Infant wide-field retinal image
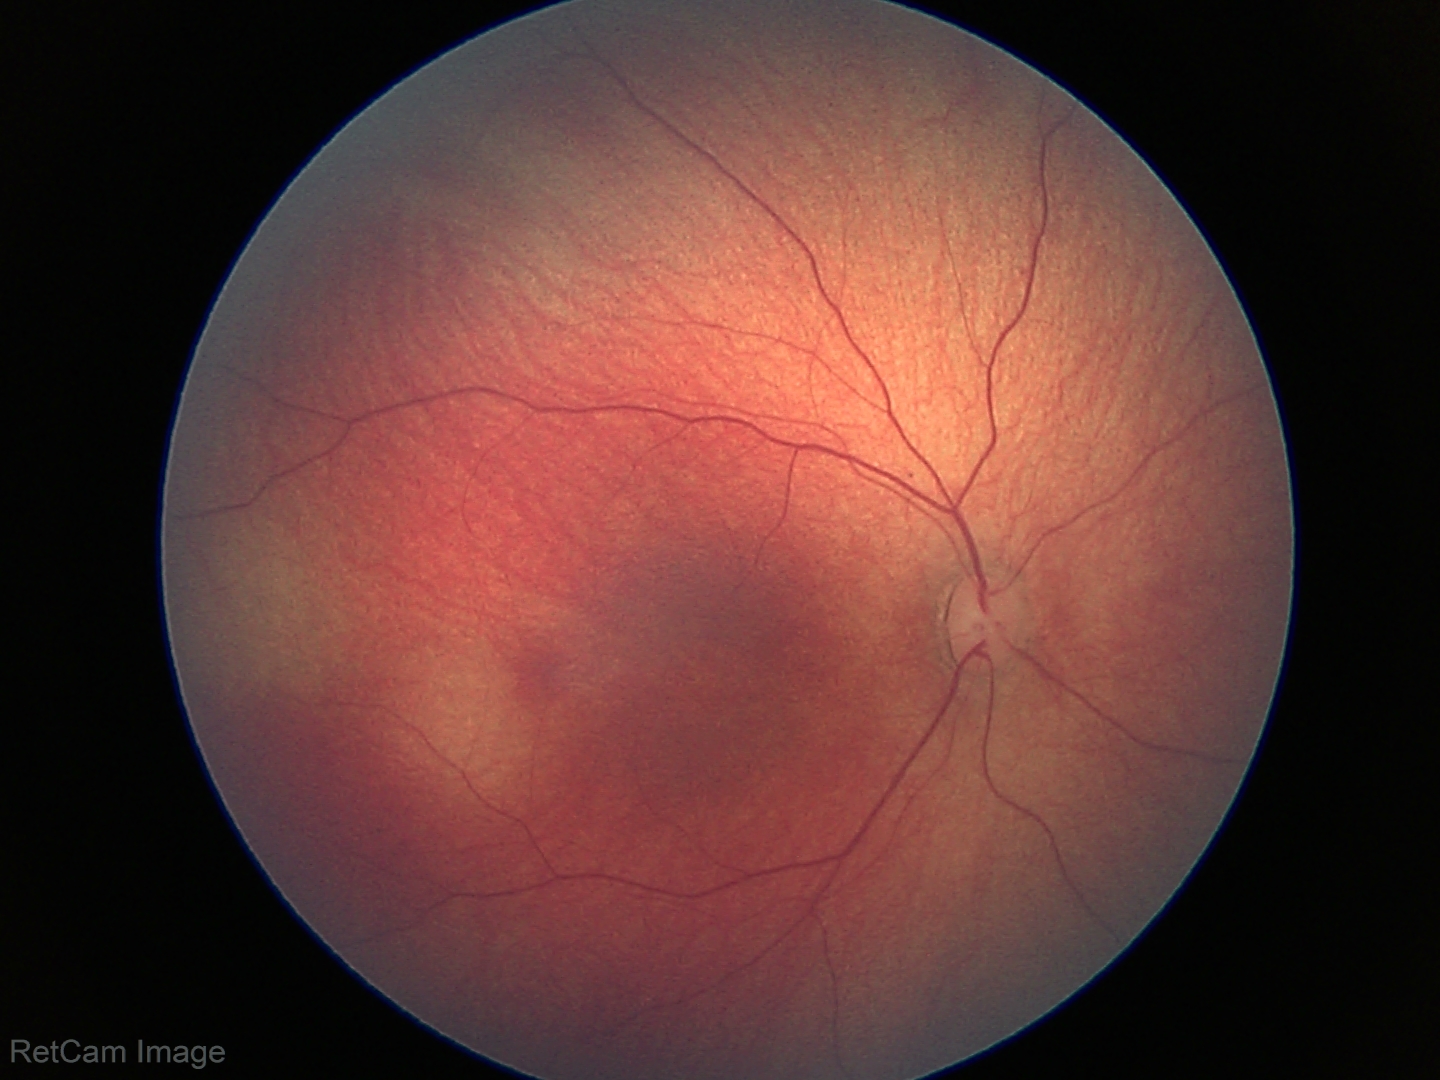 Normal screening examination.